512 x 512 pixels · color fundus photograph — 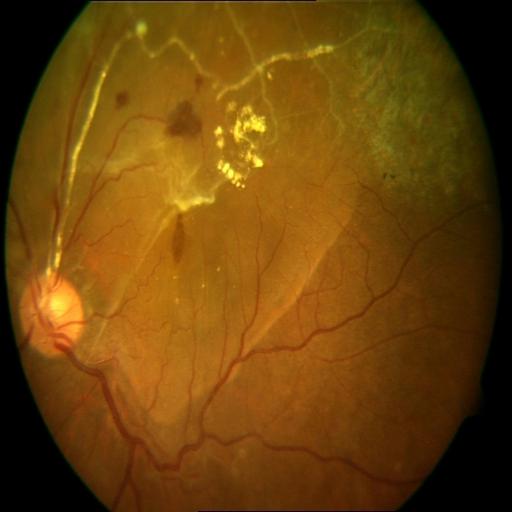

Showing hemorrhagic retinopathy (HR), retinal traction (RT), and vasculitis (VS).